Retinal fundus photograph, 45 degree fundus photograph.
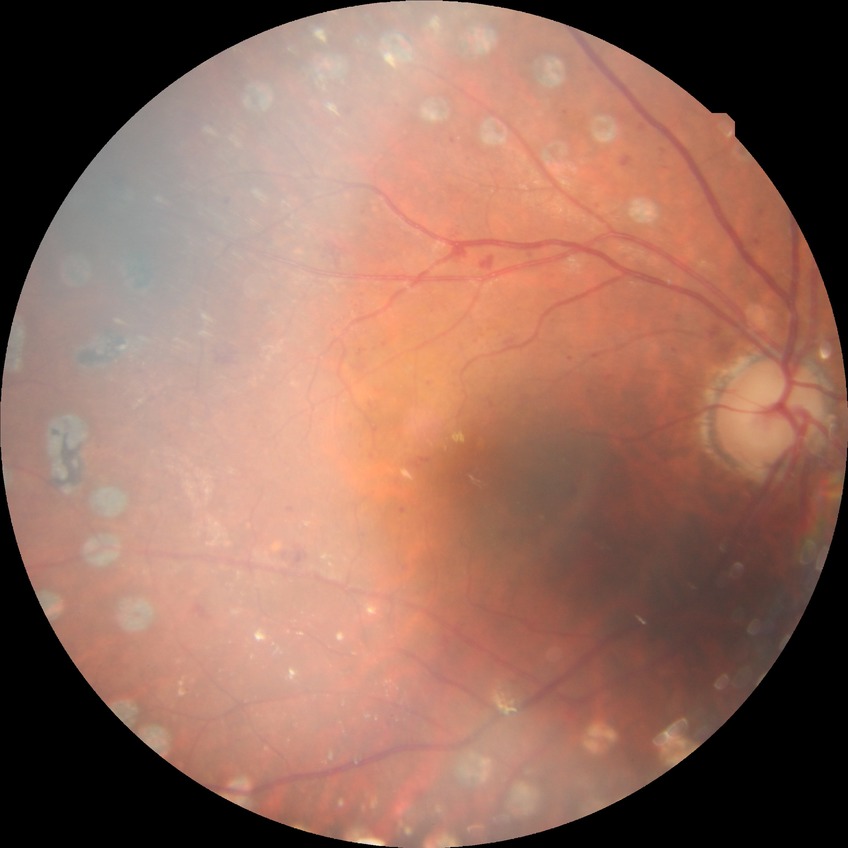

Retinopathy grade is proliferative diabetic retinopathy.